45° FOV.
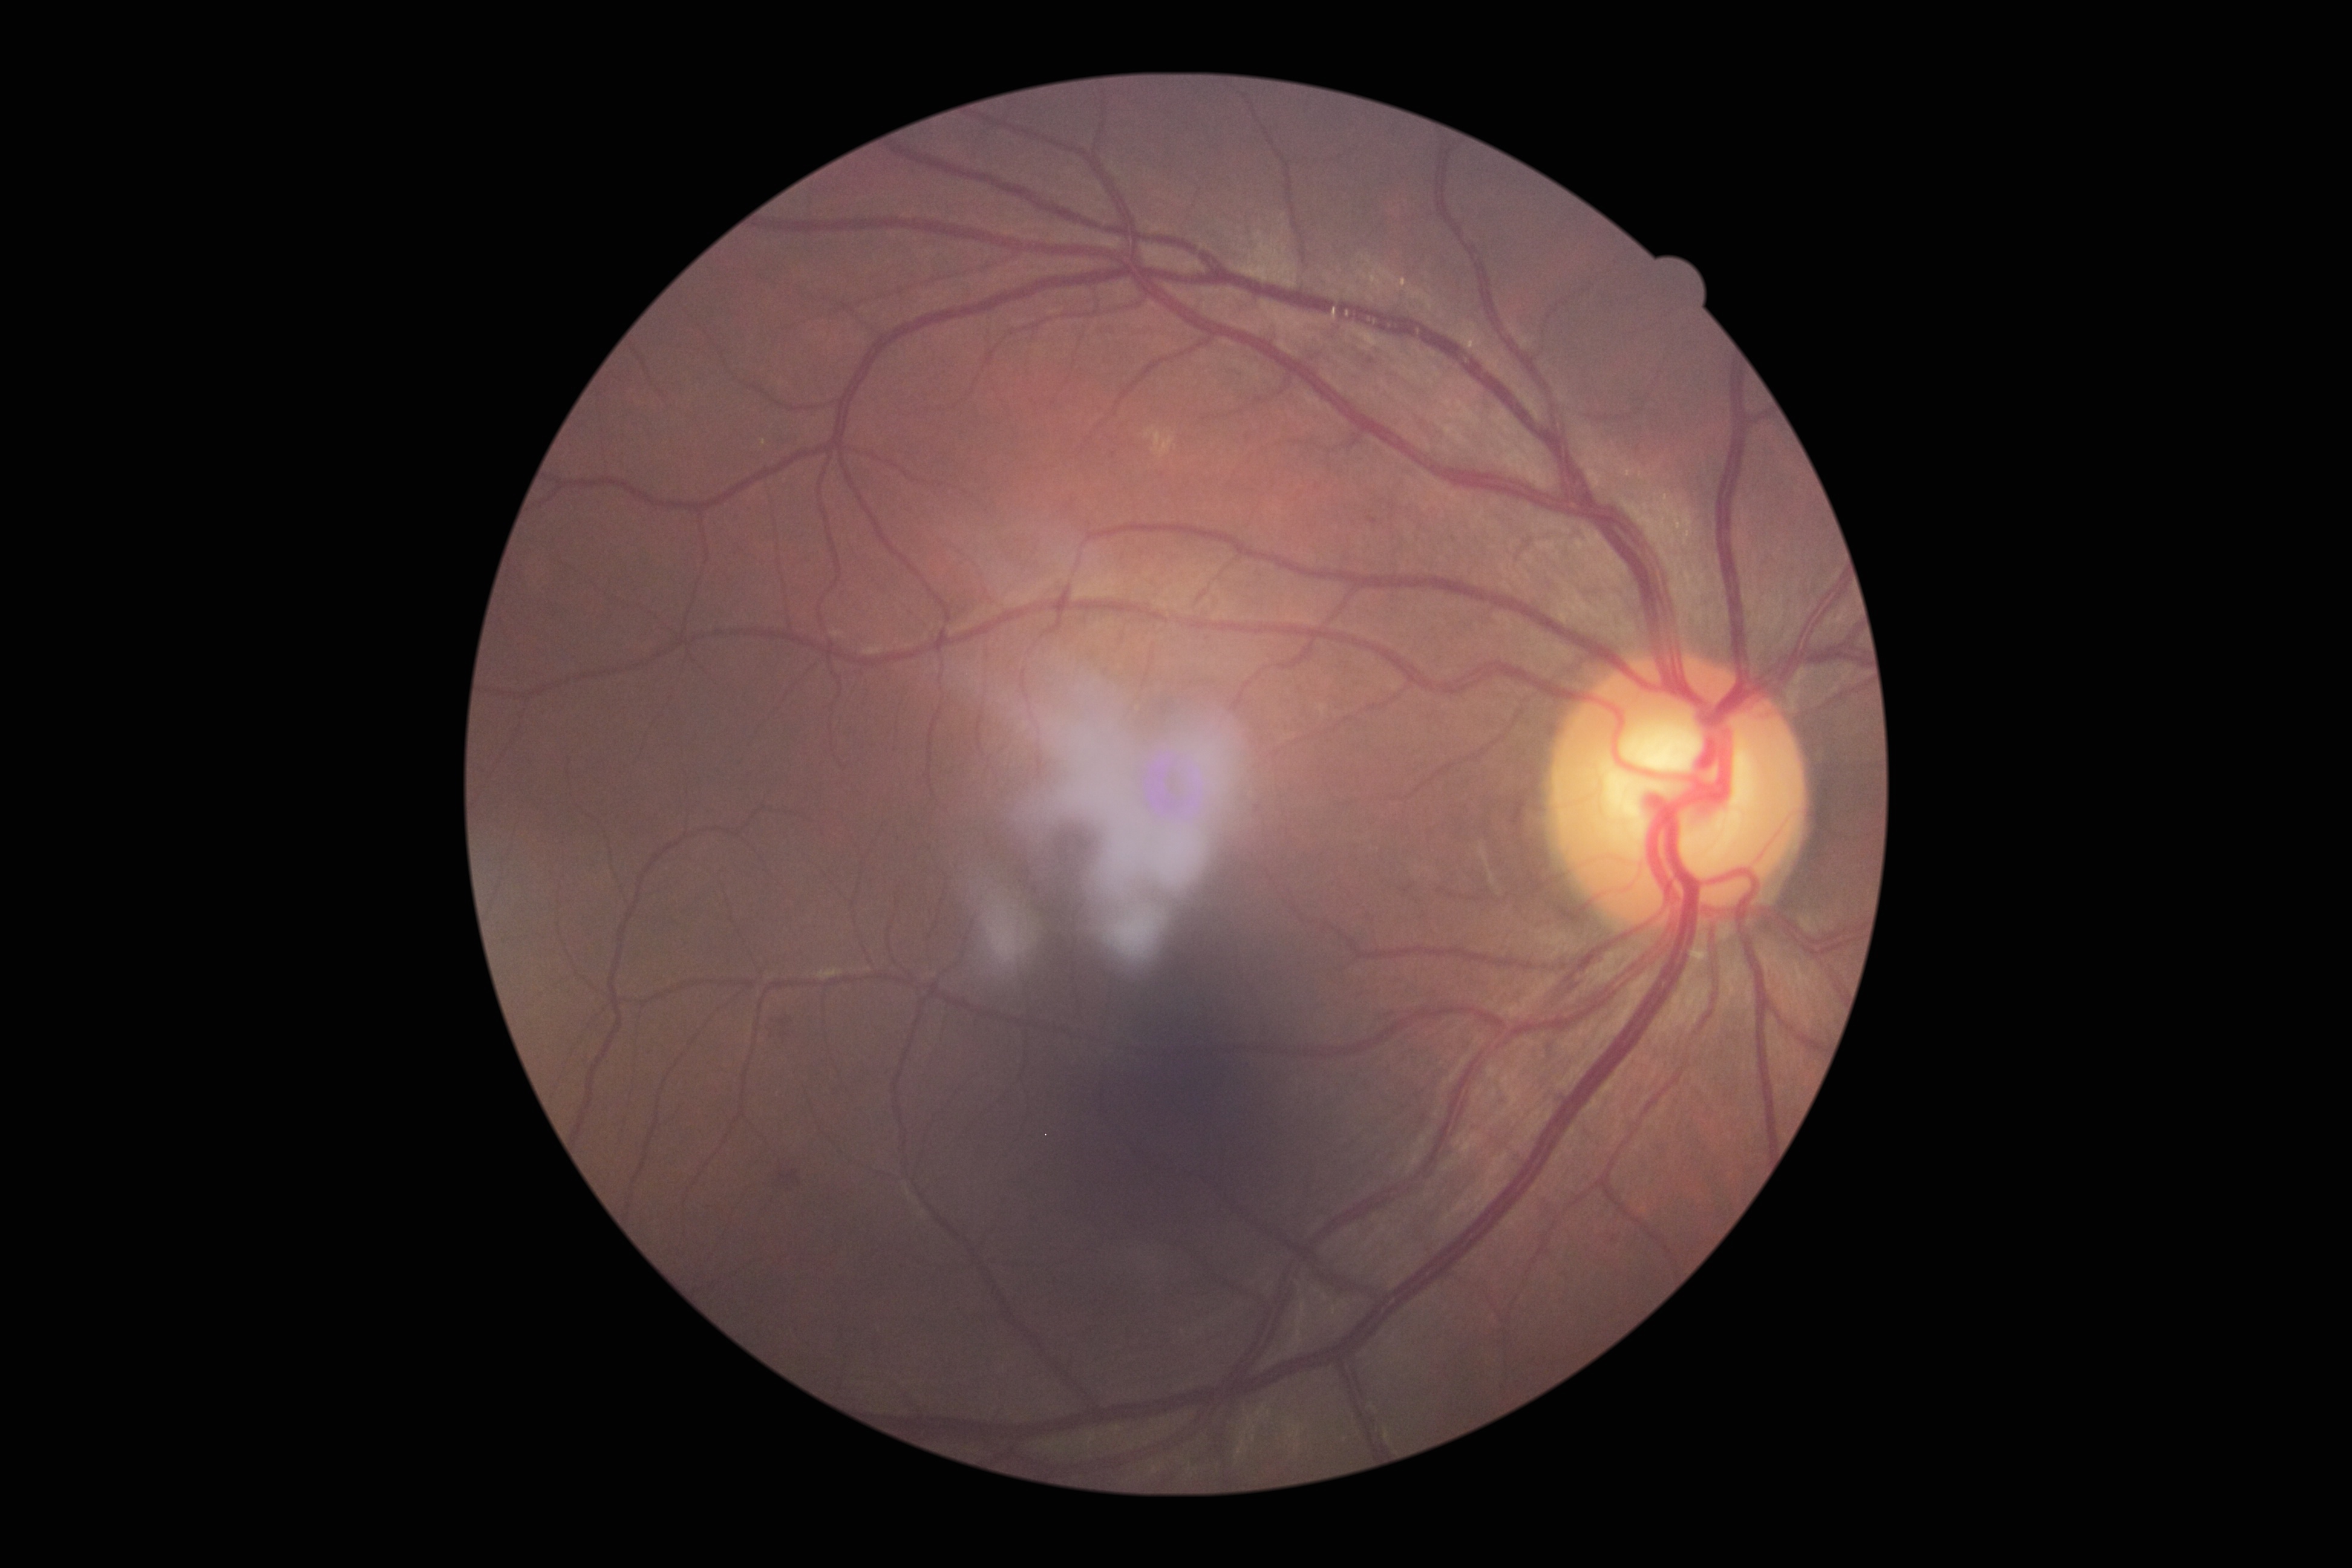

DR=grade 2.